Color fundus photograph. 2048x1536px.
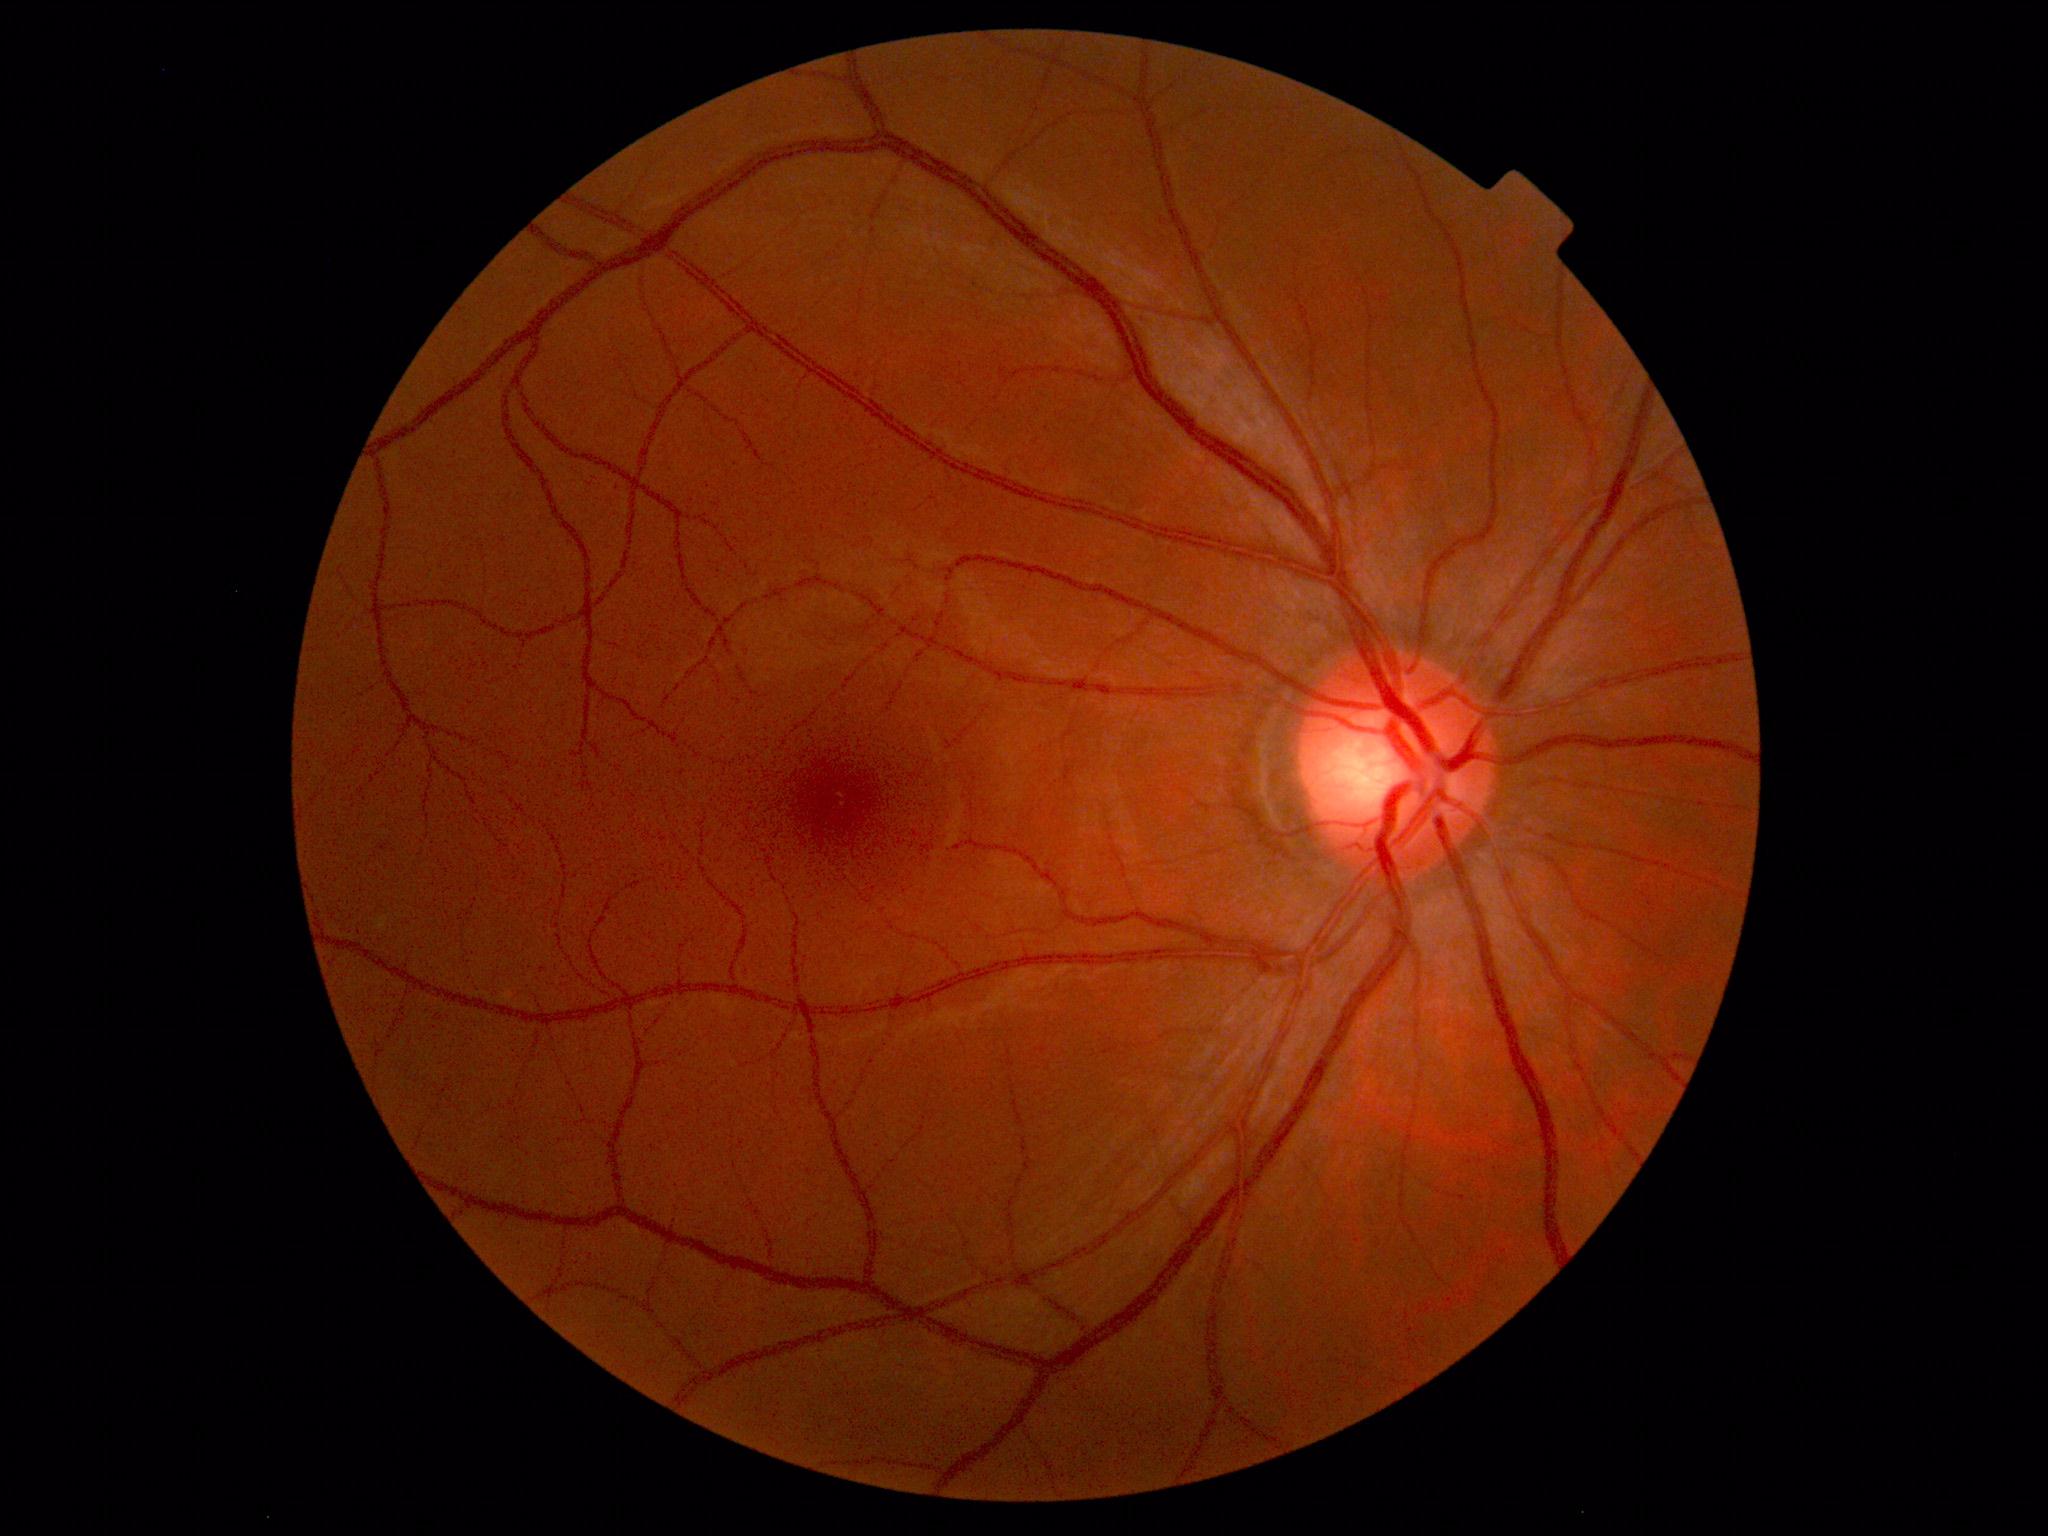

Normal fundus. No pathology identified.